Infant wide-field retinal image — 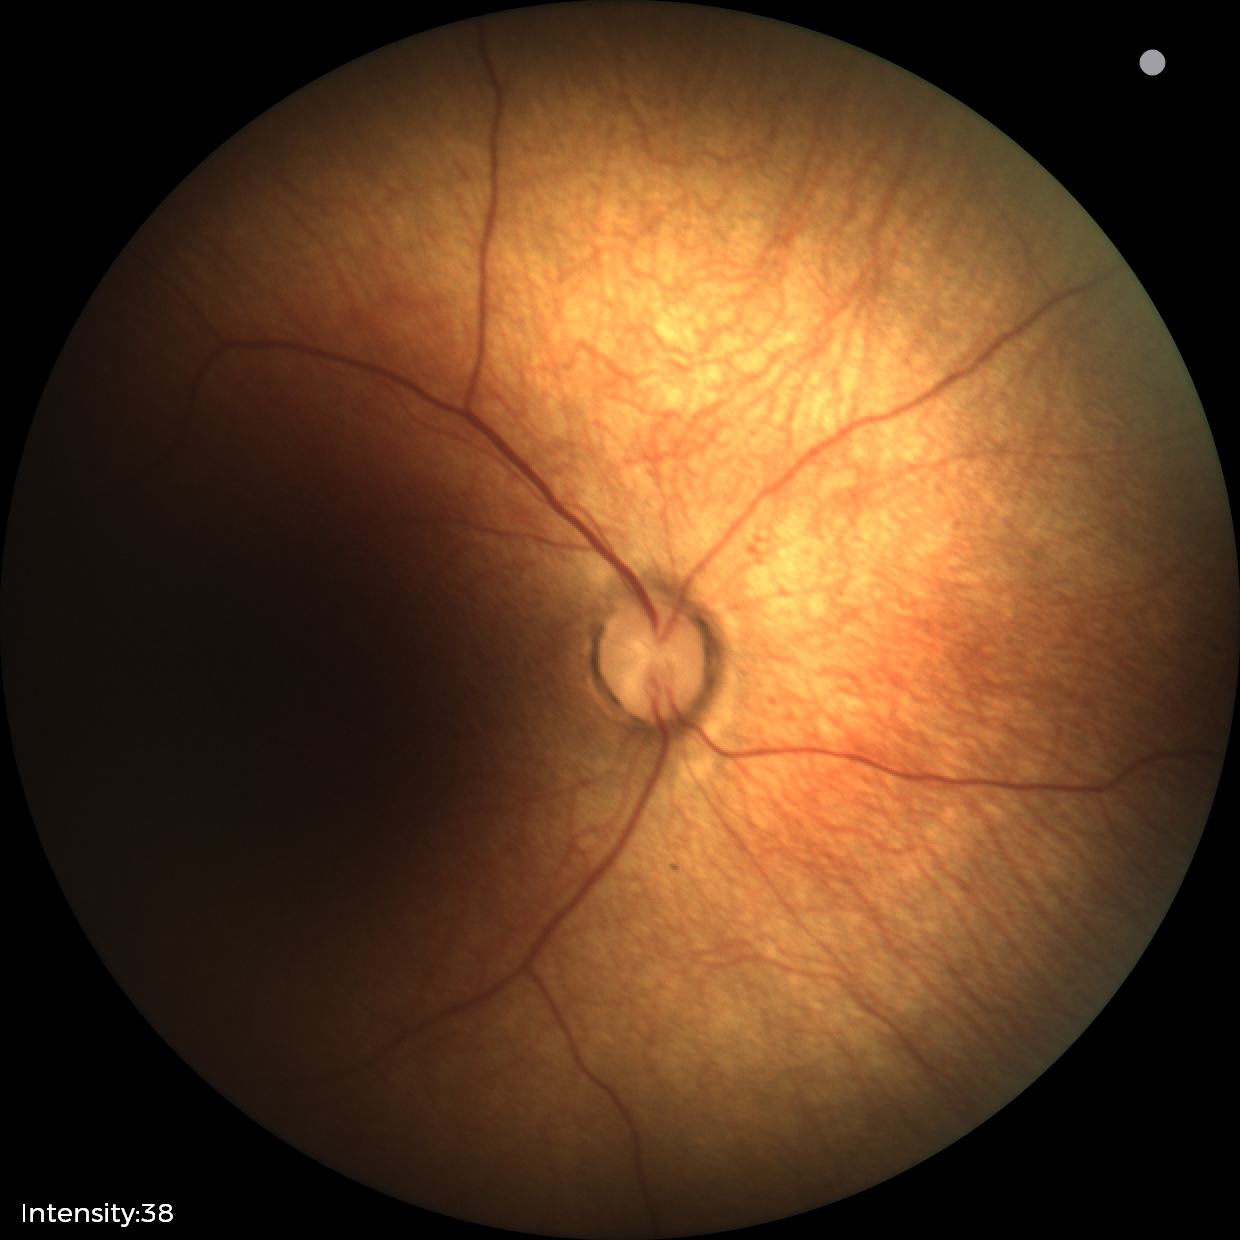
Q: What is the screening diagnosis?
A: normal retinal appearance